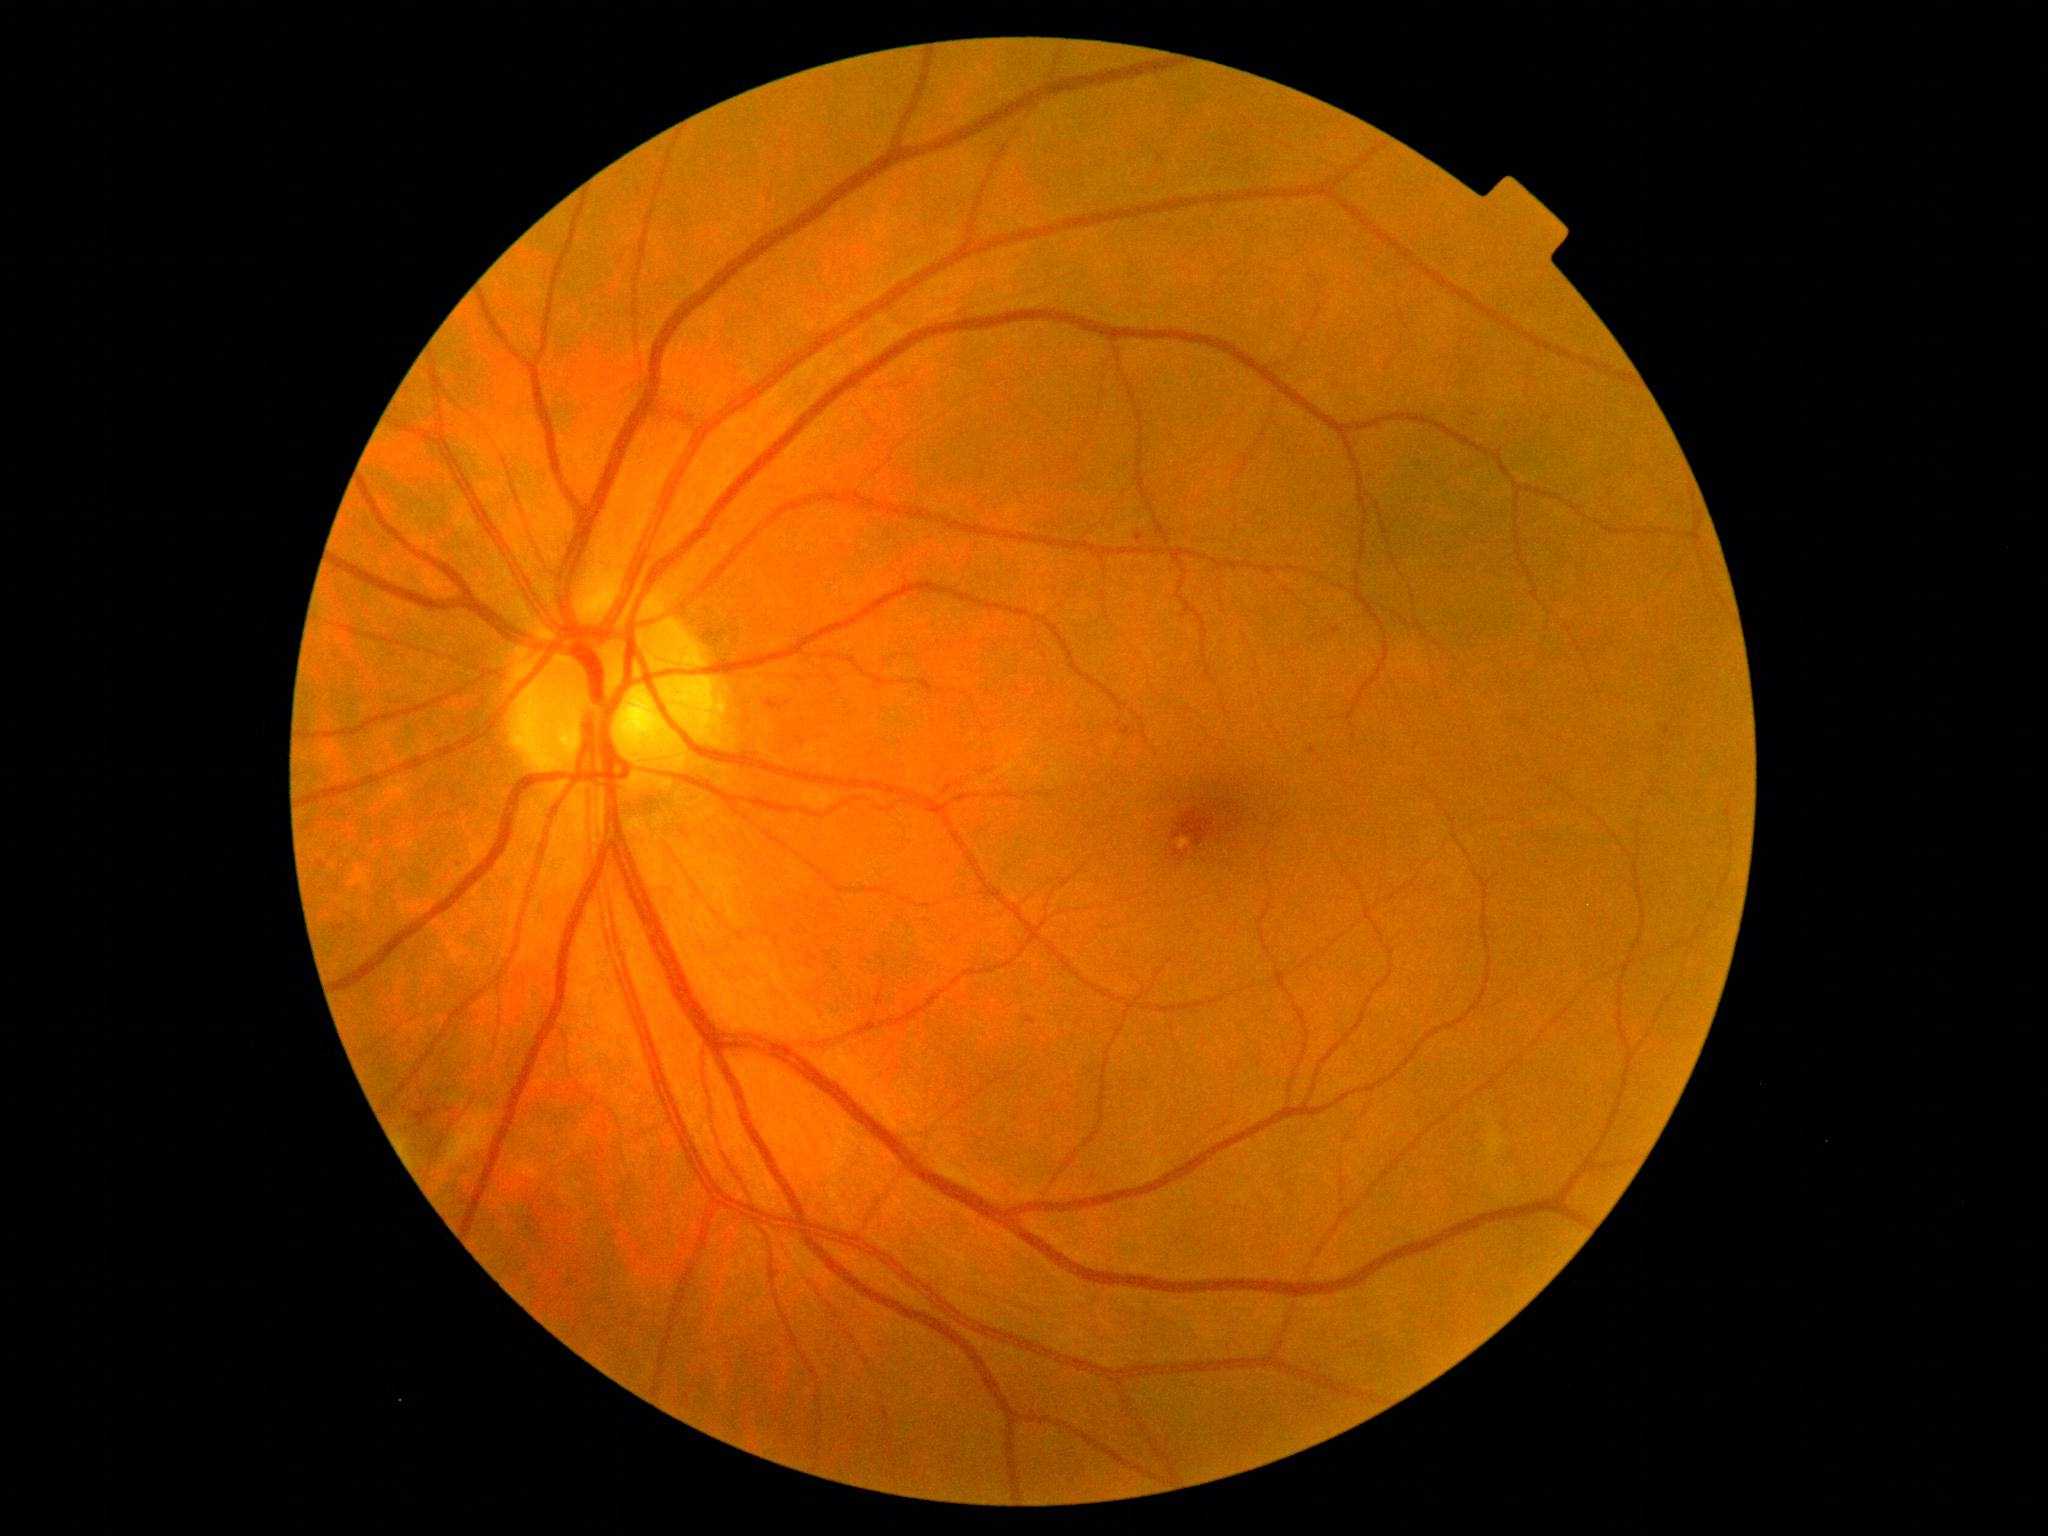 retinopathy: 2.